Posterior pole view; Topcon TRC-50DX; fundus photo; 50° field of view — 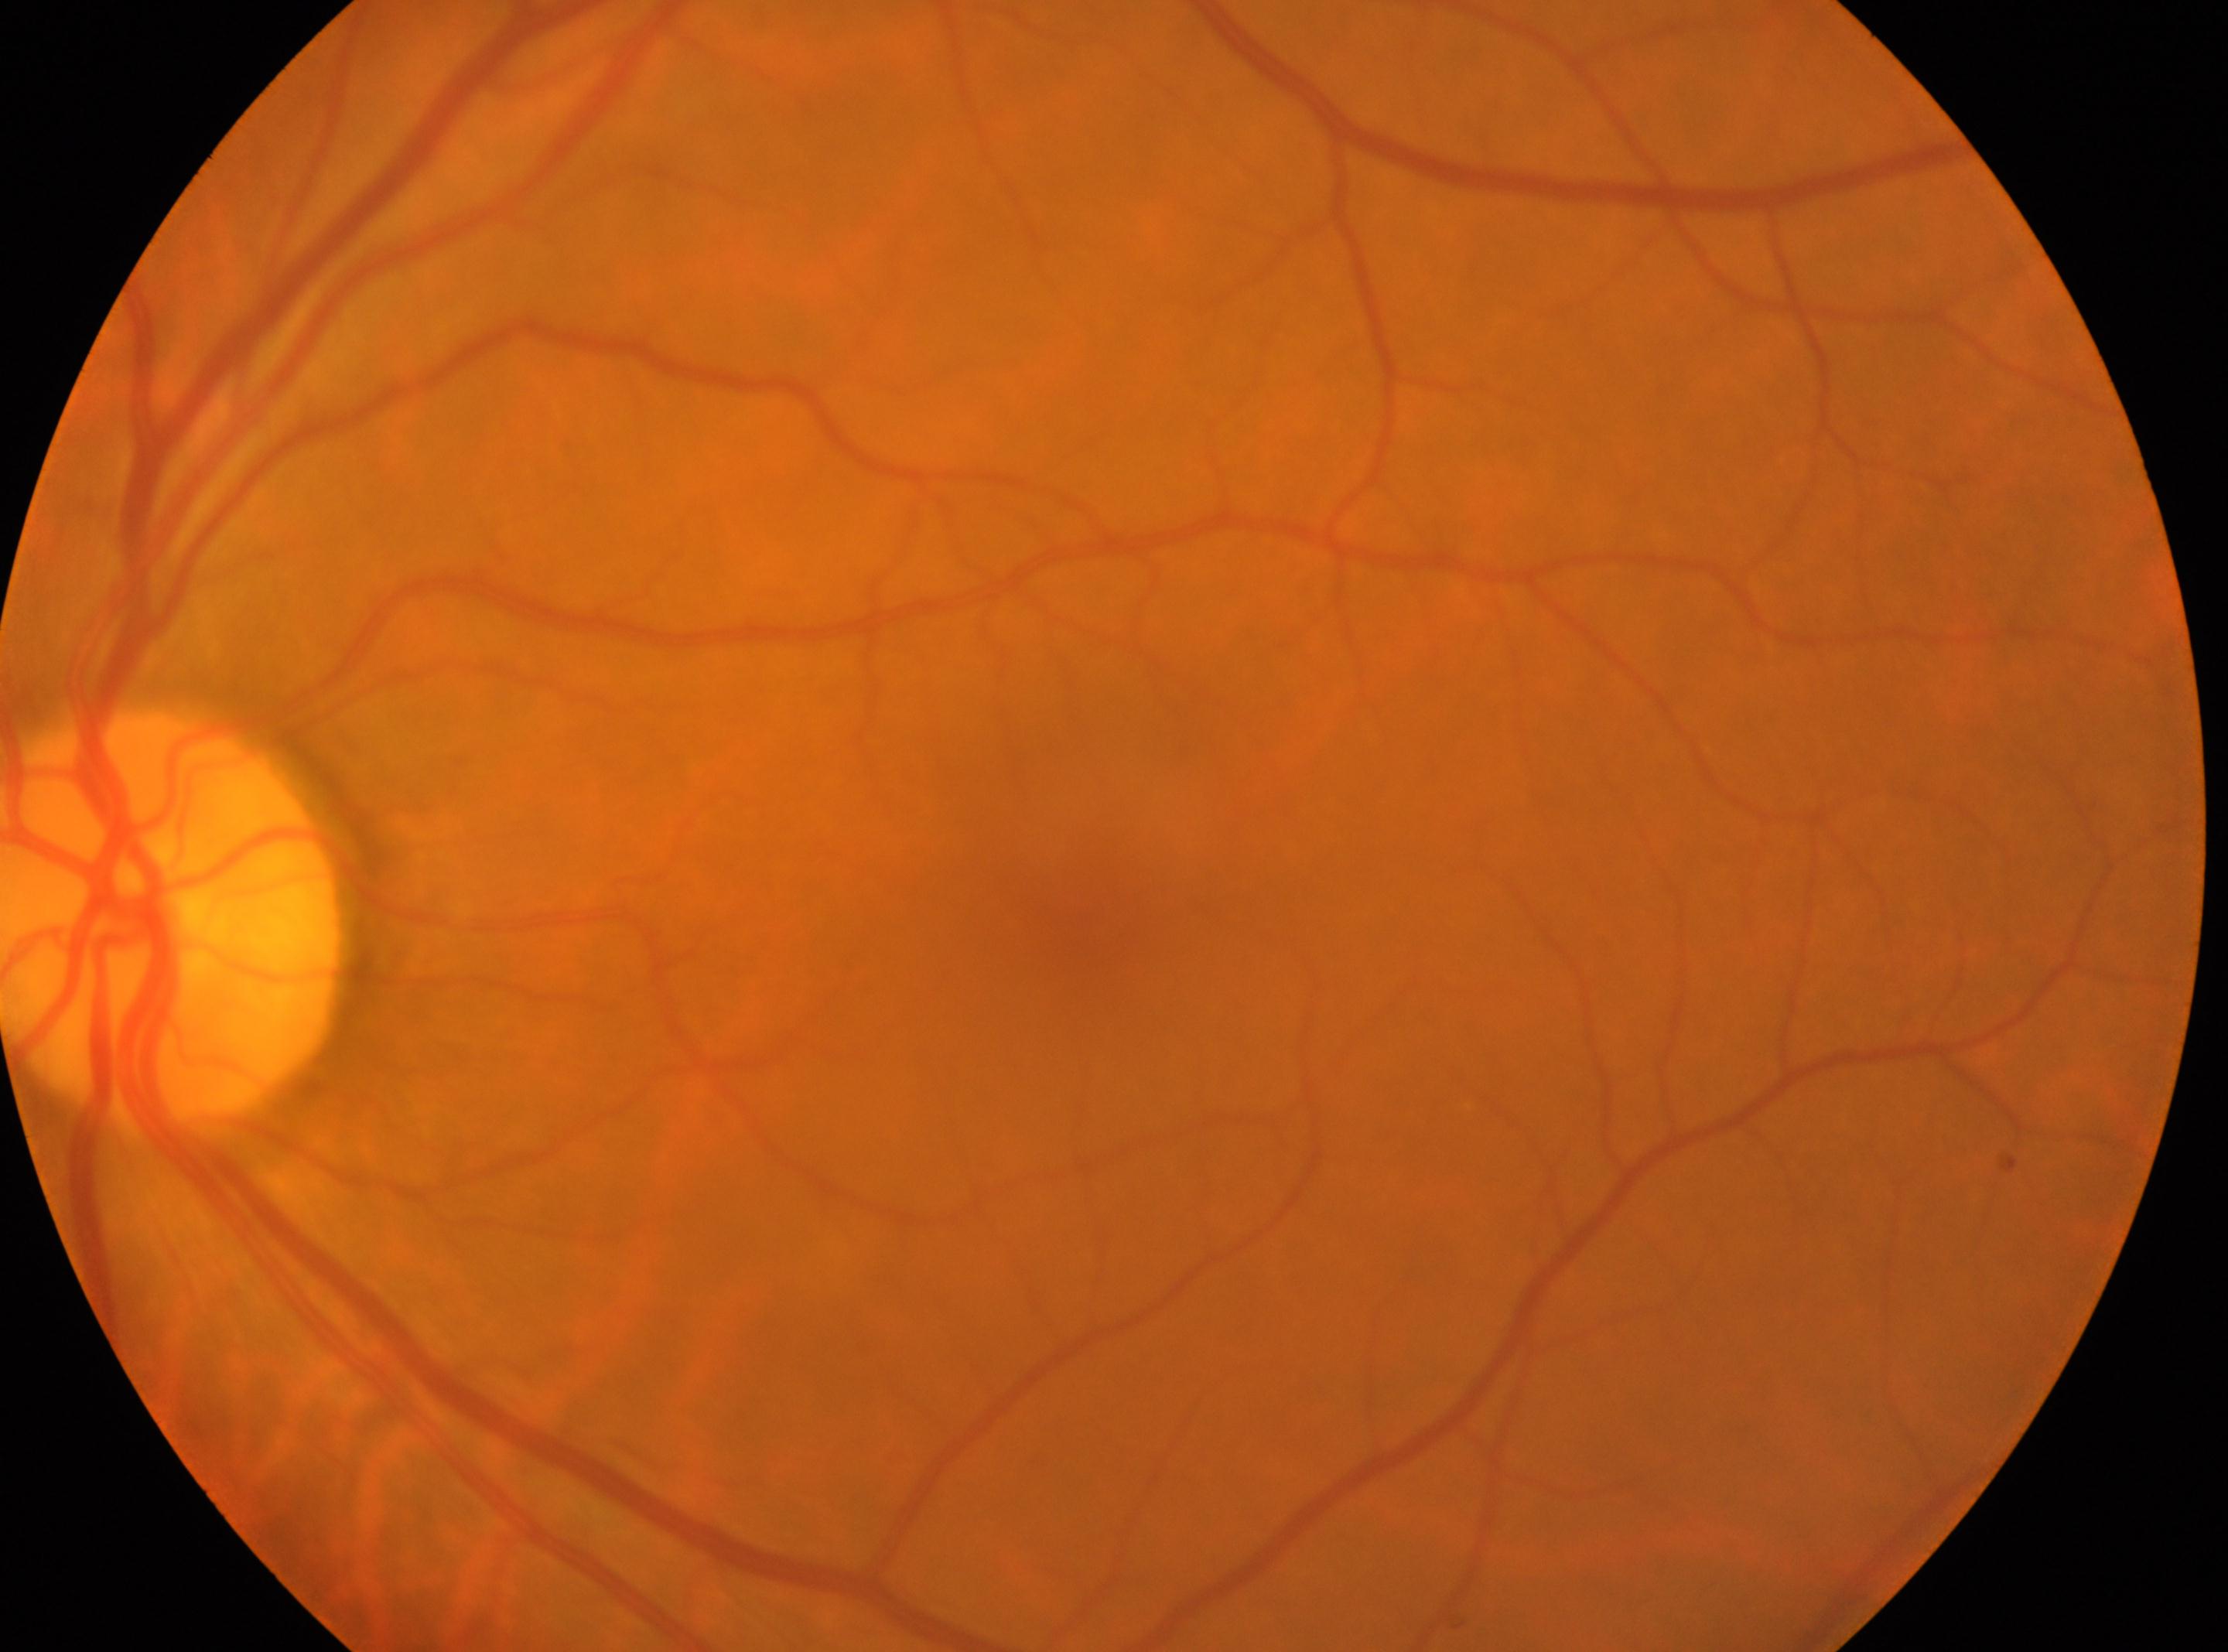 DR is grade 0.
Optic disc: x=173, y=913.
Imaged eye: left eye.
Macula center located at x=1082, y=902.